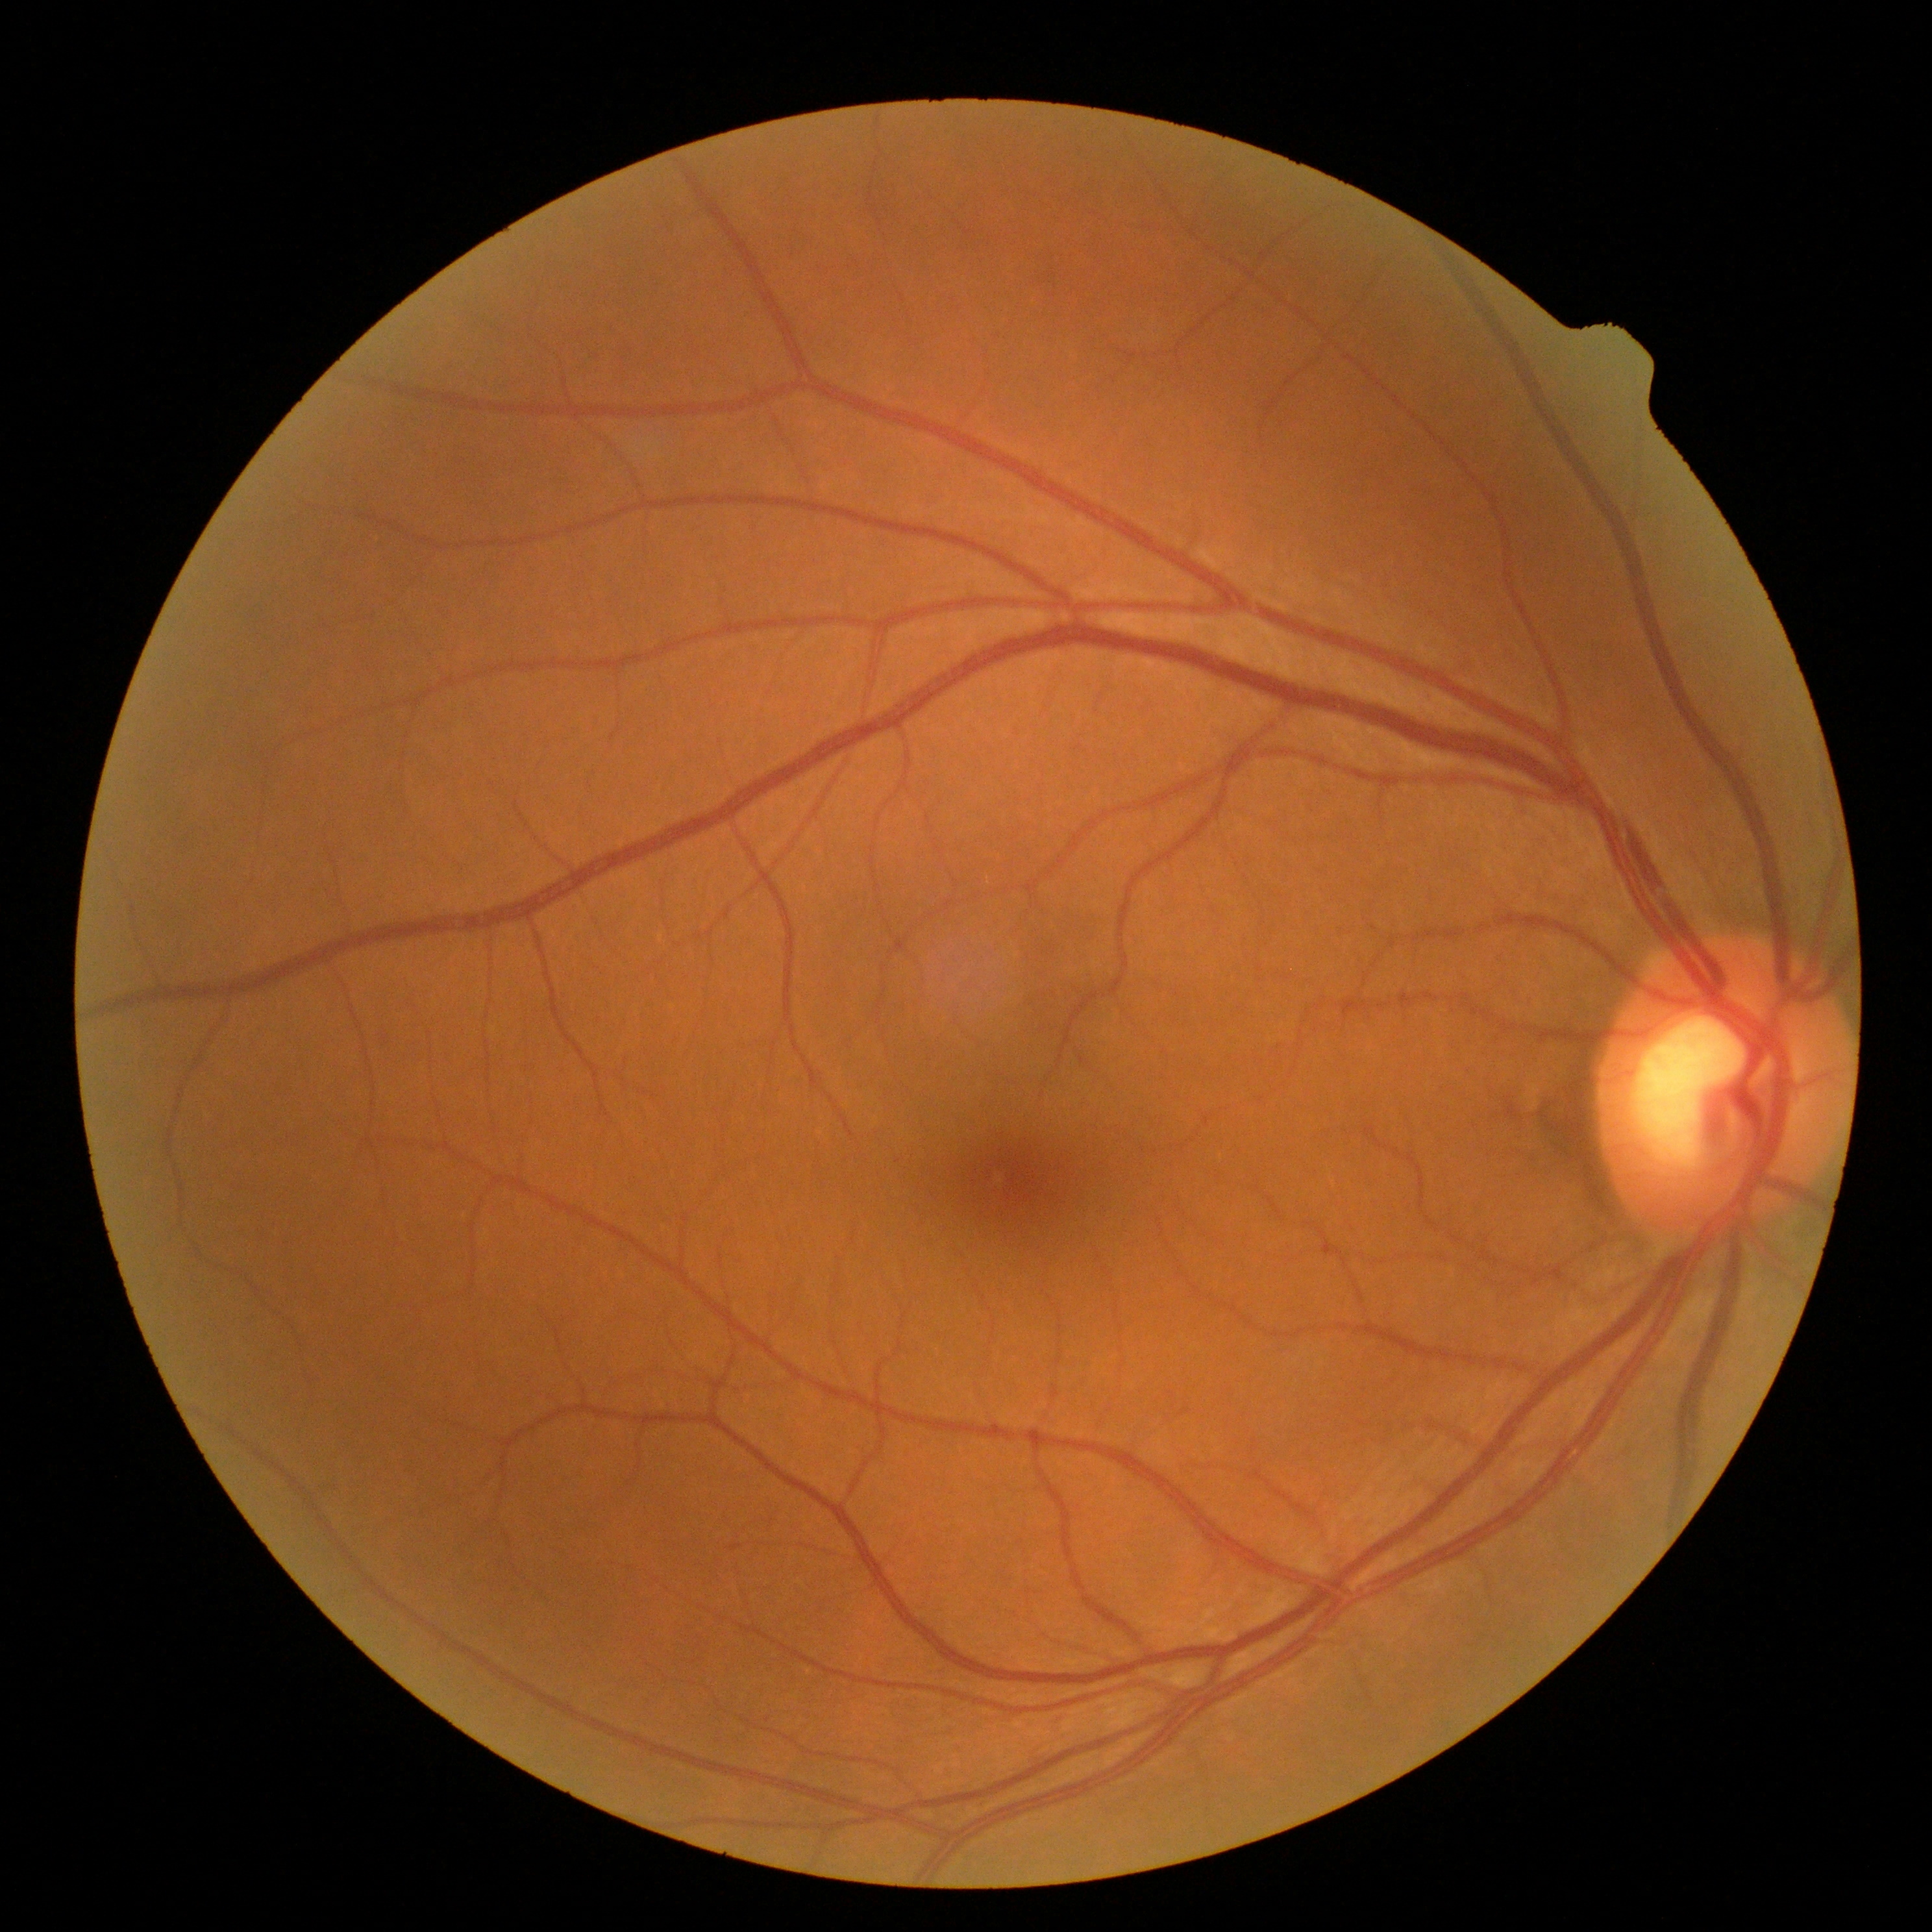

Diabetic retinopathy is grade 0 (no apparent retinopathy).